Acquired on the Phoenix ICON; wide-field fundus photograph of an infant; 1240x1240px:
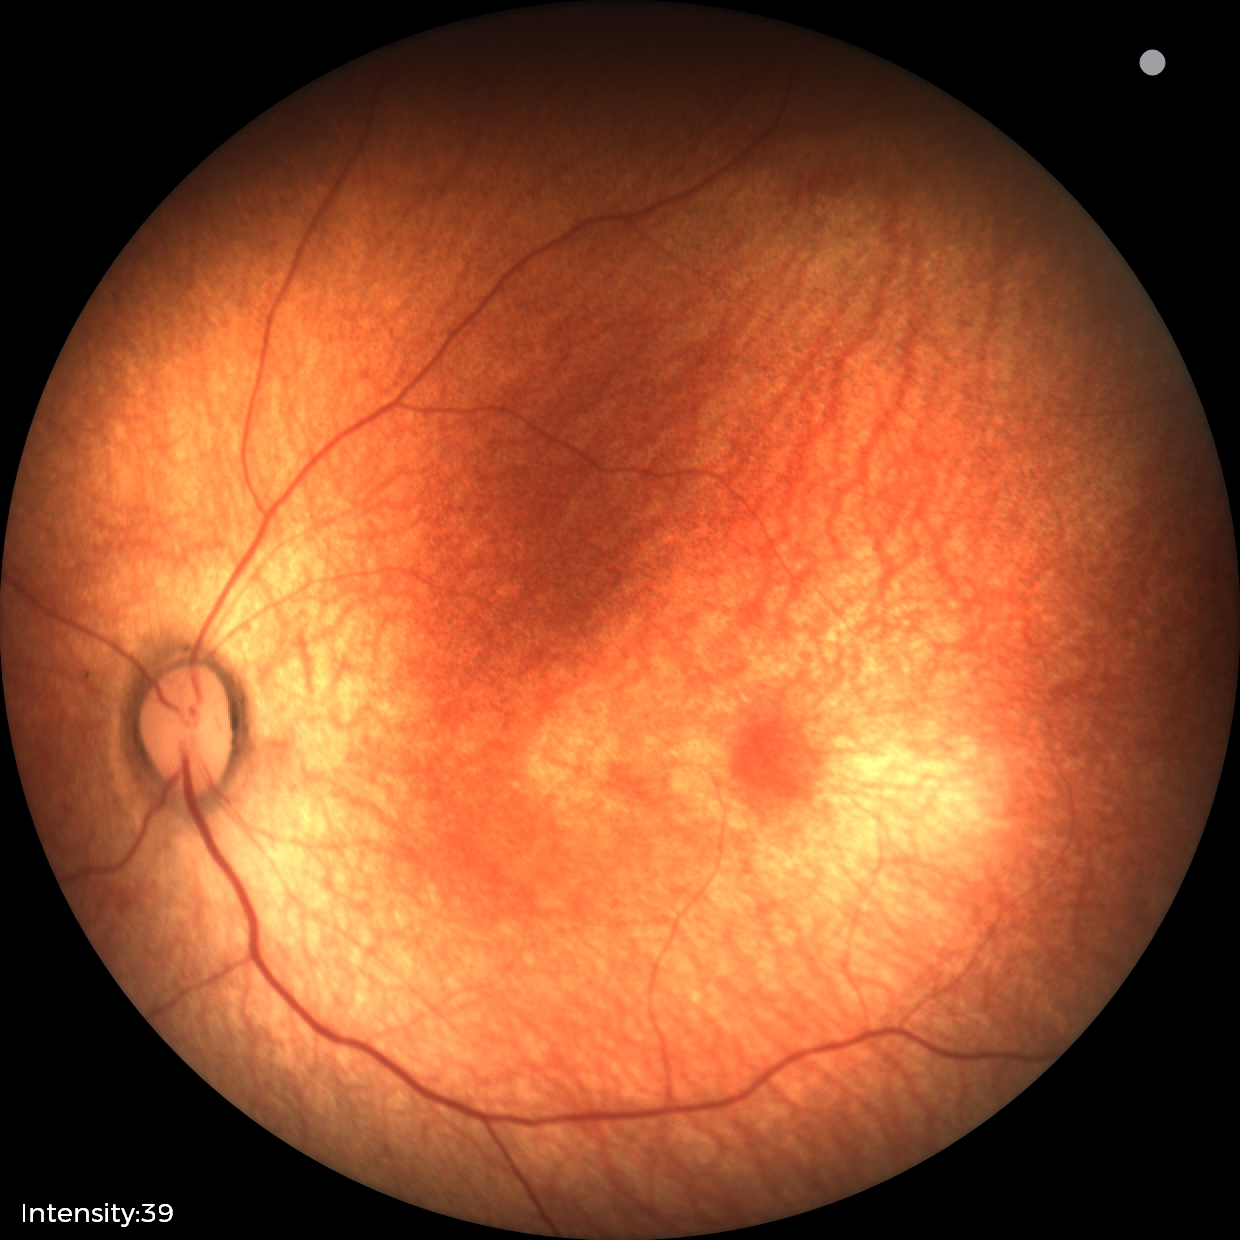 Assessment: physiological finding.